2228x1652; mydriatic (tropicamide and phenylephrine)
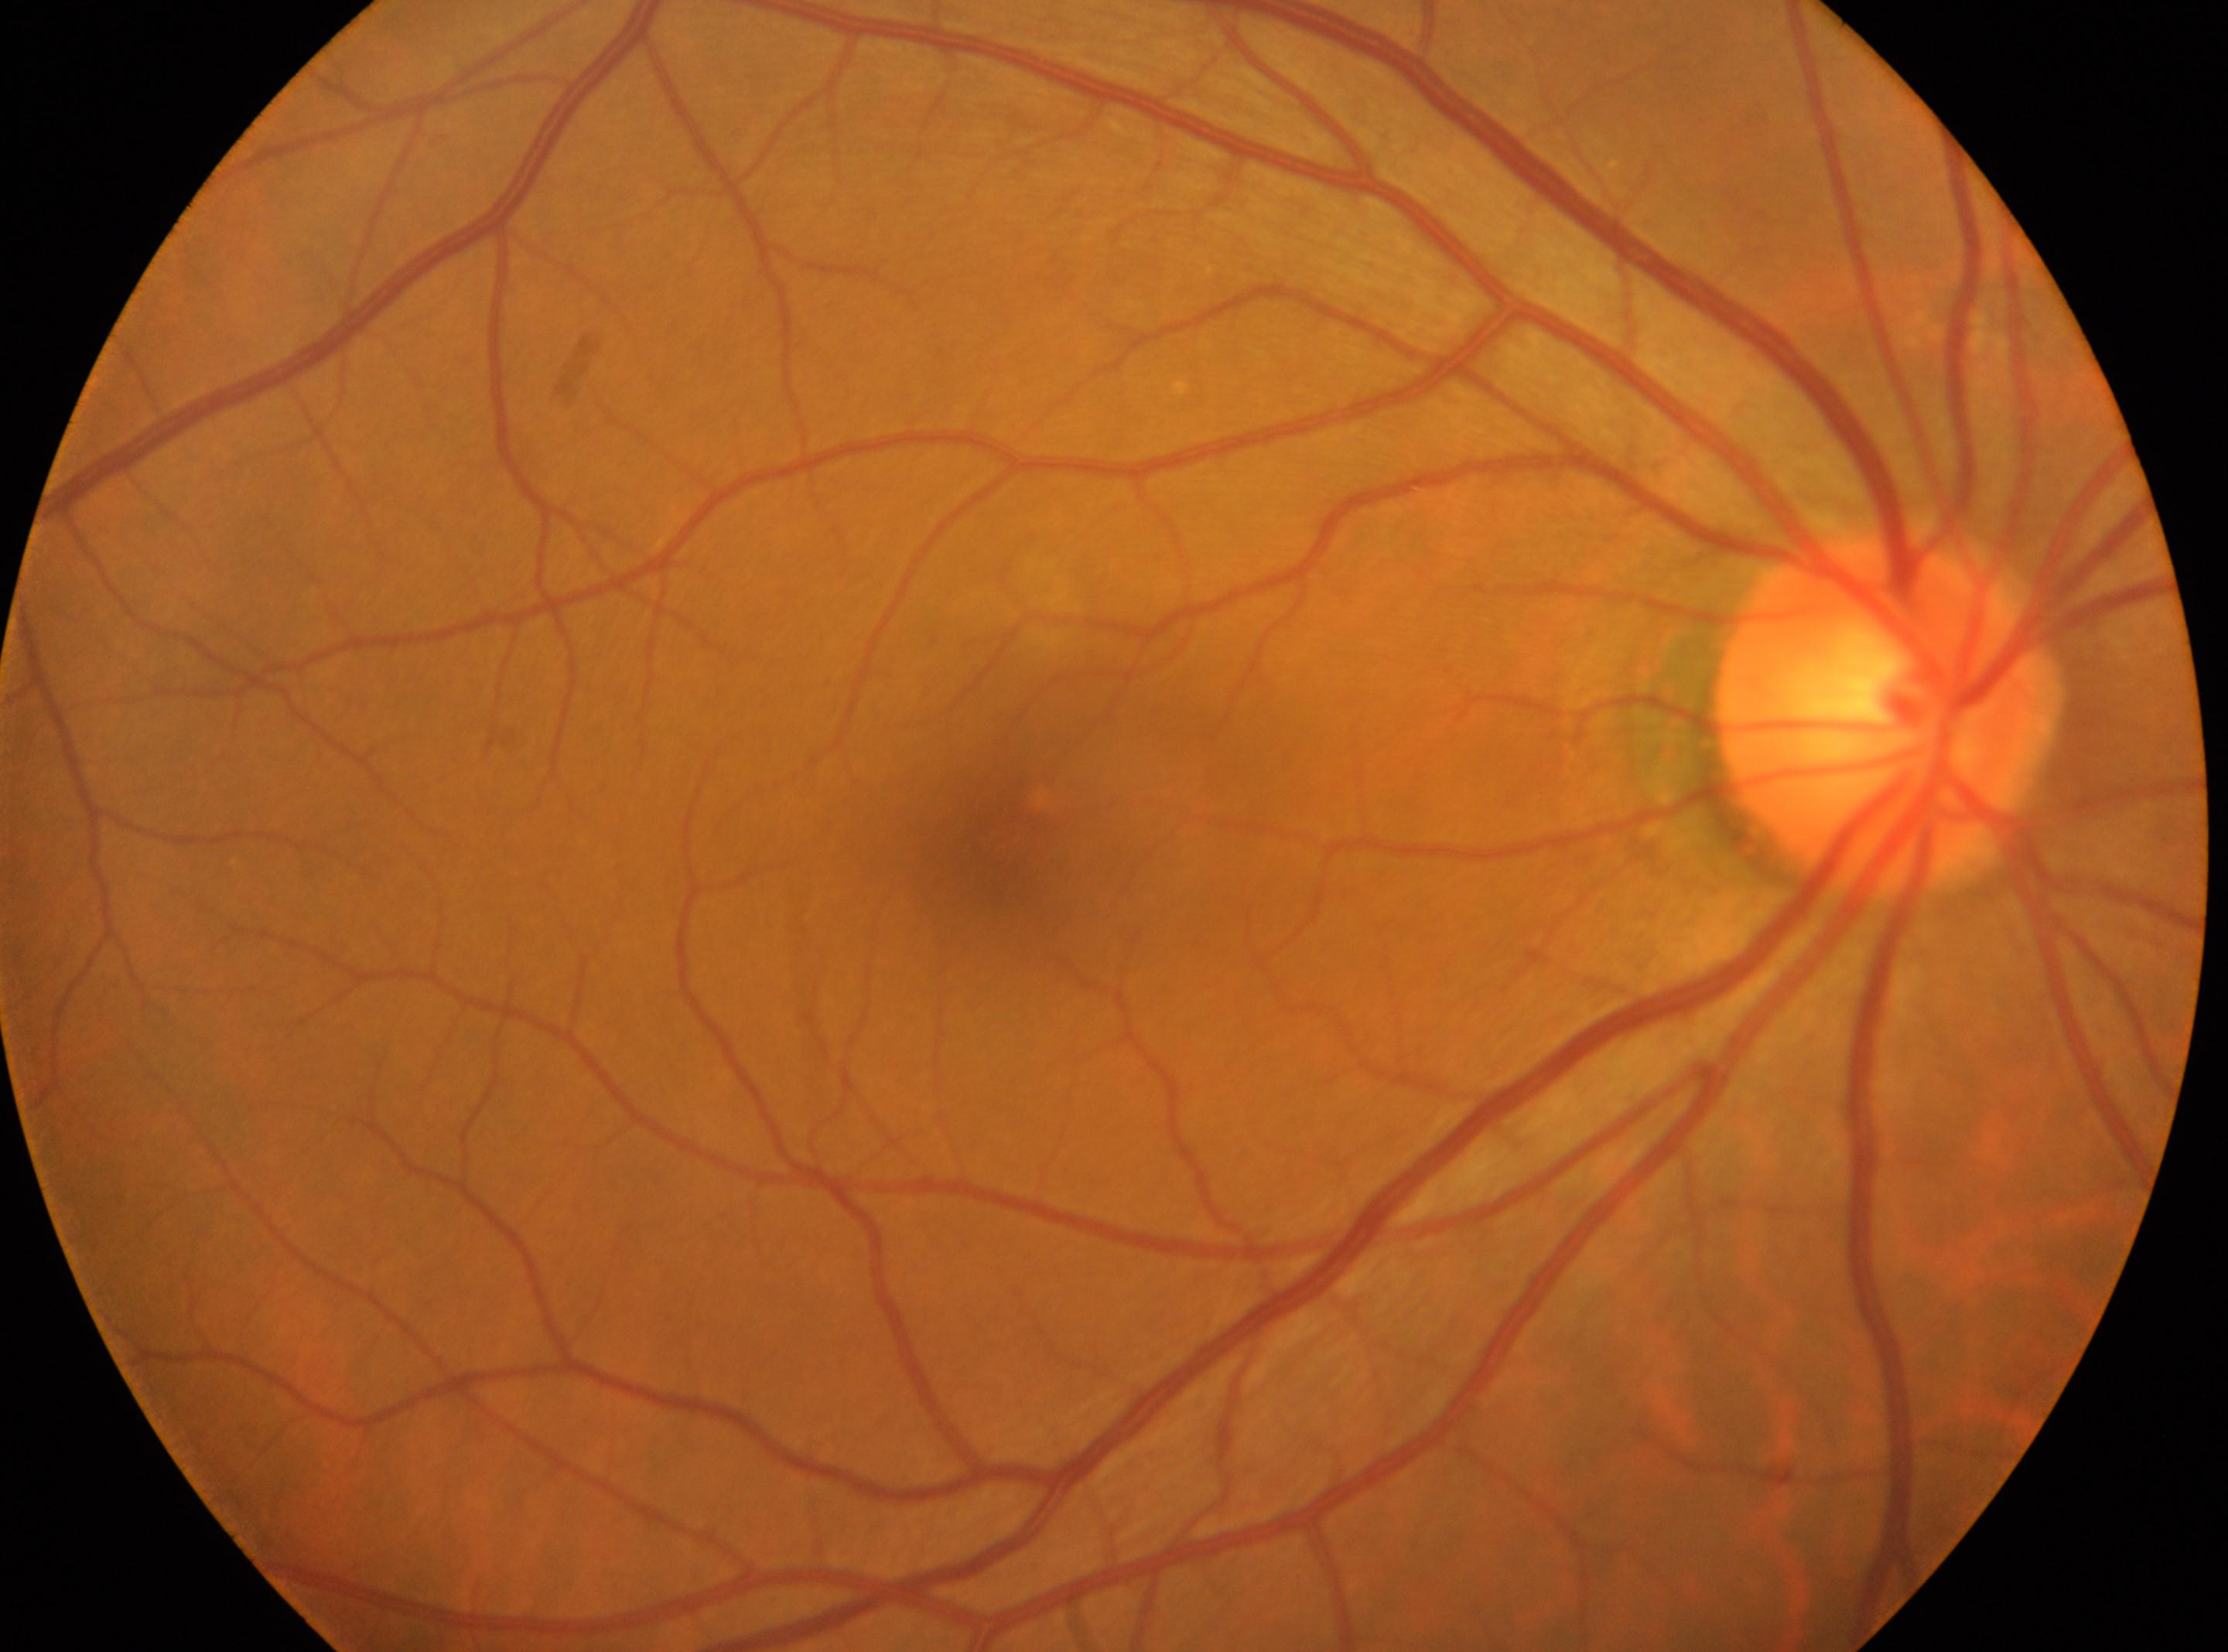

Findings:
- DR grade · 0
- DR impression · No diabetic retinal disease findings
- laterality · oculus dexter
- disc center · (1878,718)
- foveal center · (996,848)